2184 x 1690 pixels.
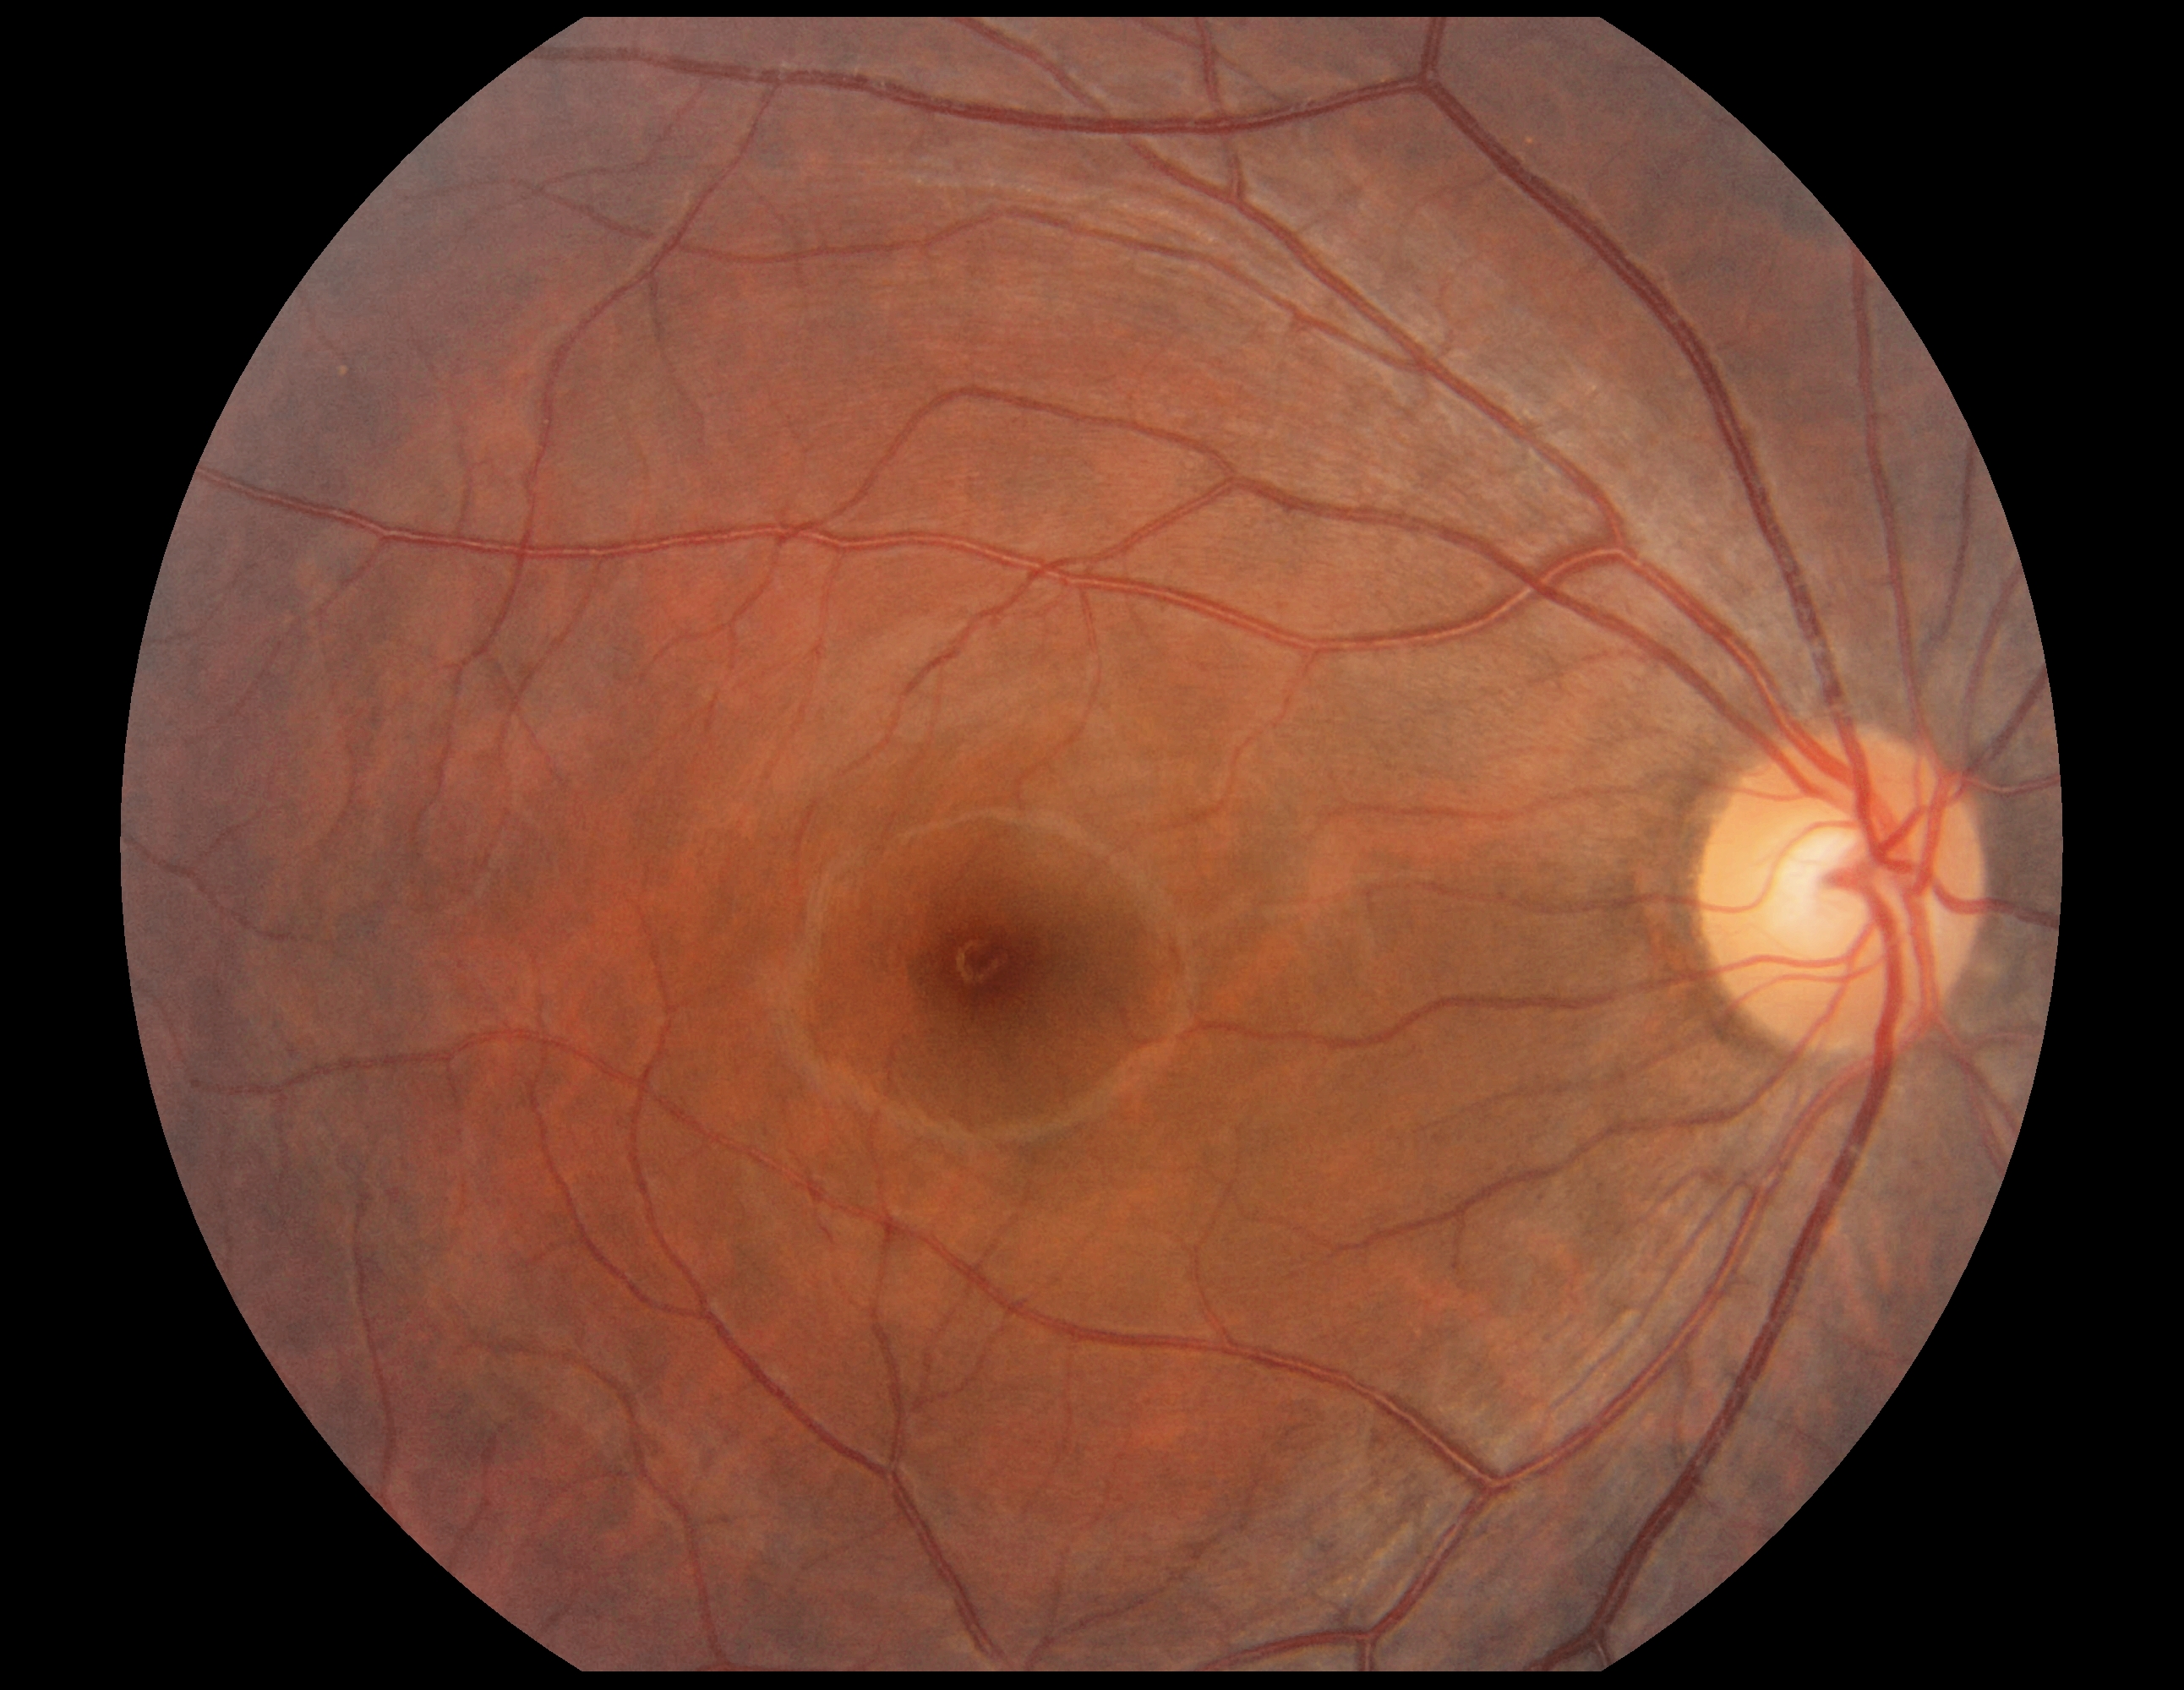
No DR findings.
Diabetic retinopathy (DR): 0.